45-degree field of view · retinal fundus photograph — 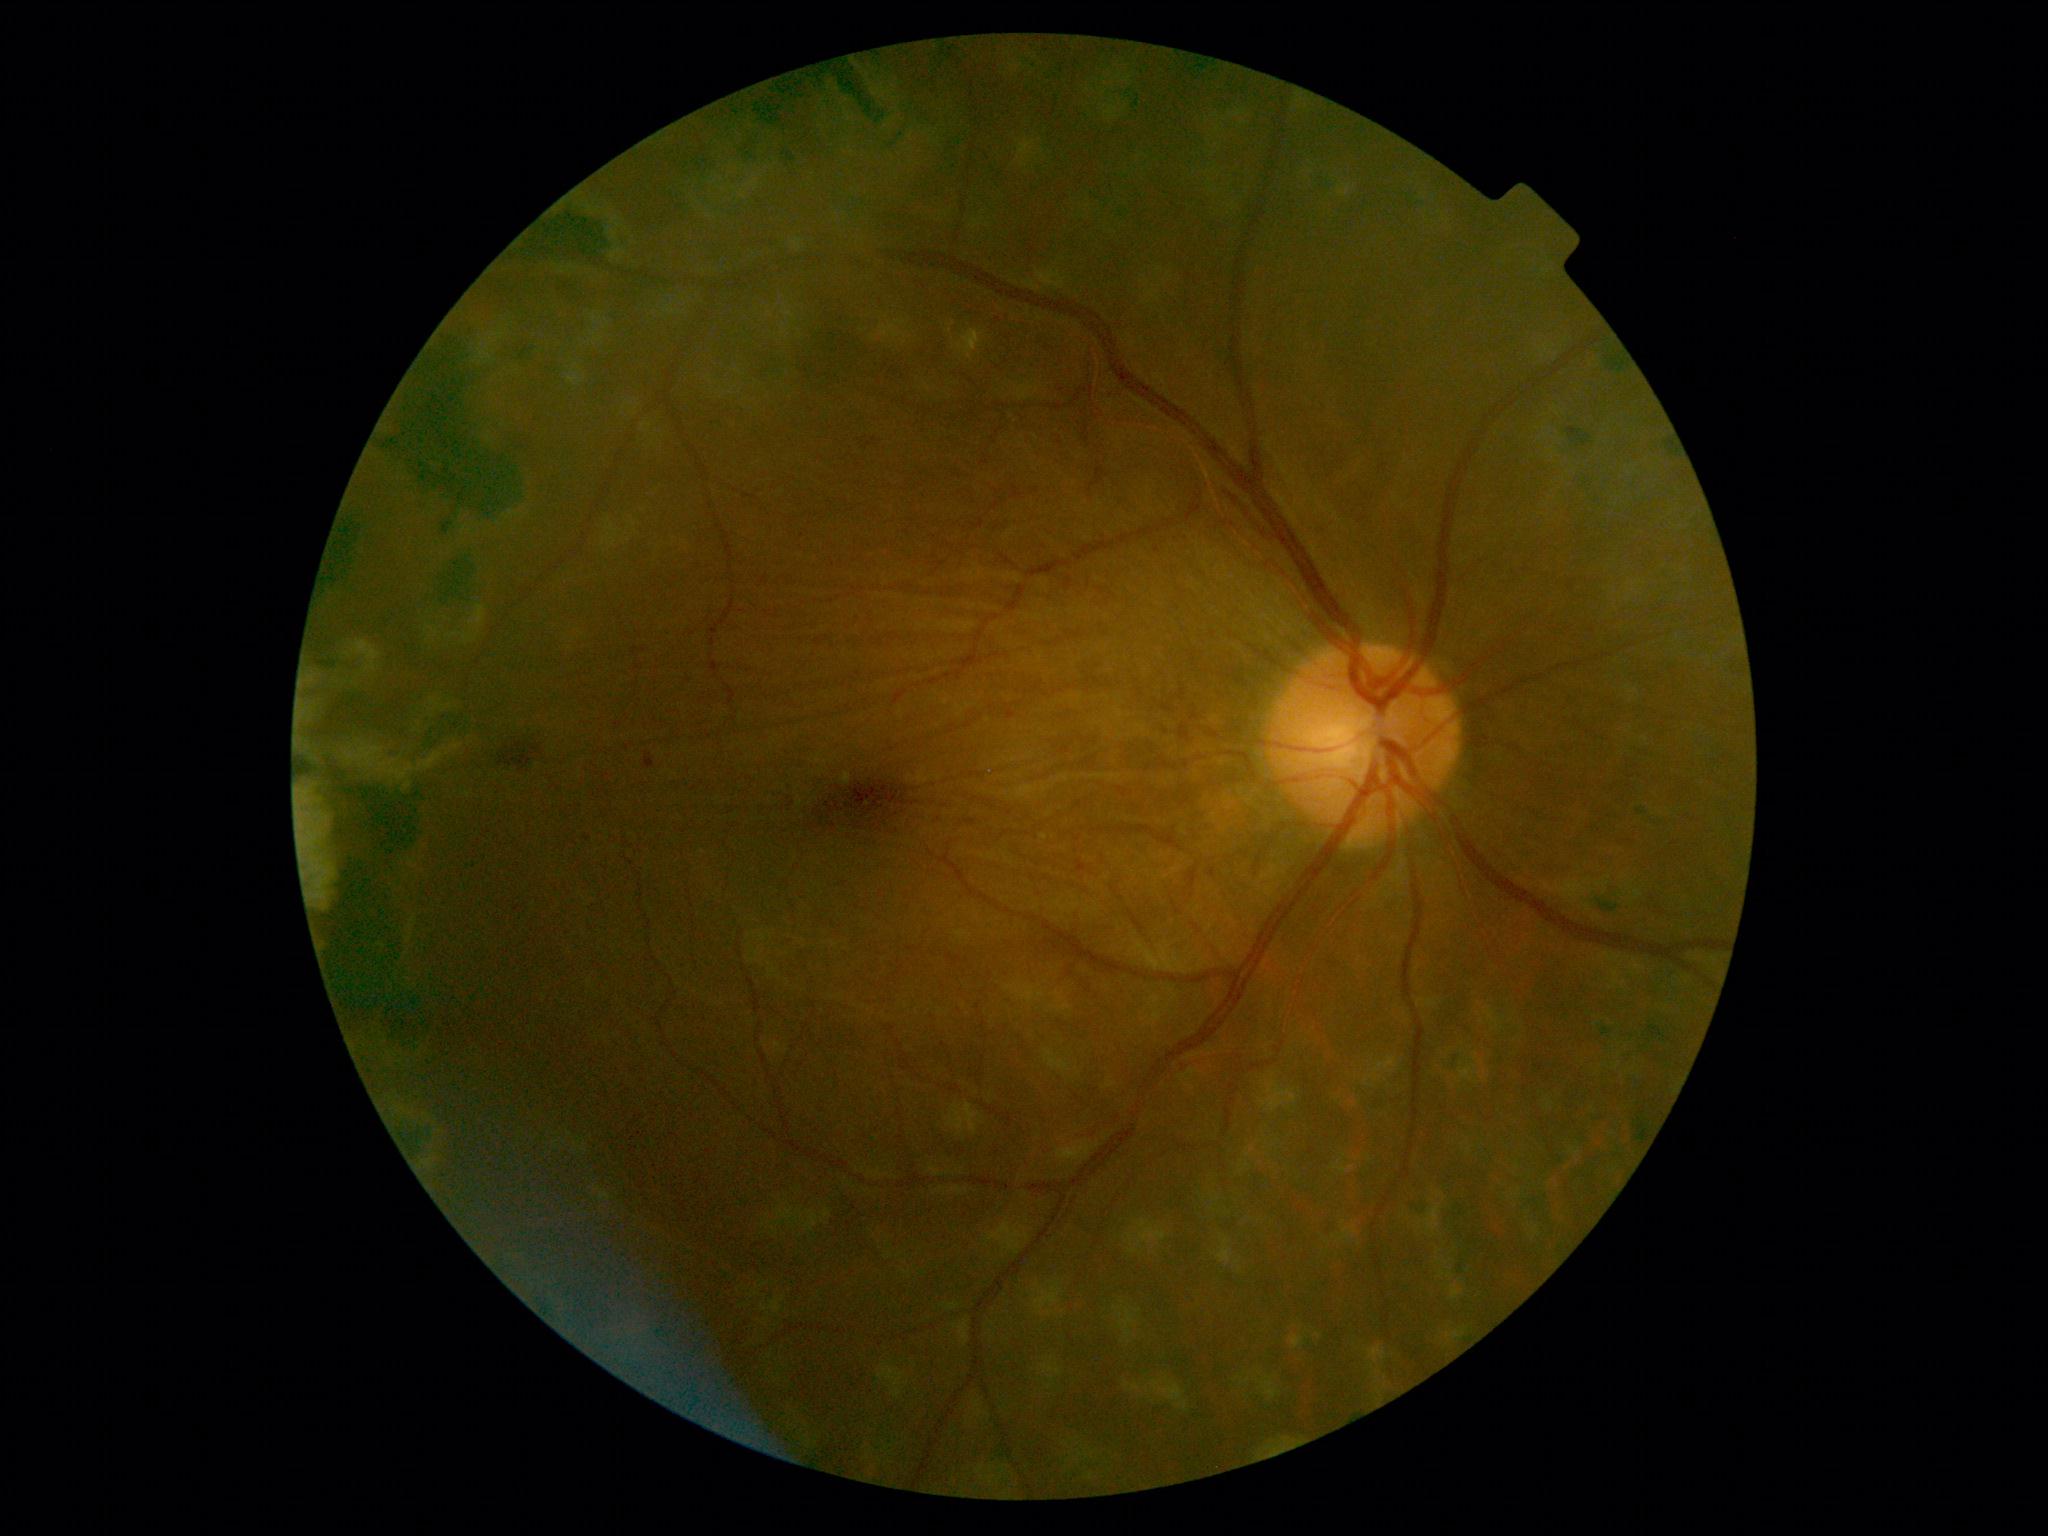
dr_grade: 2 — more than just microaneurysms but less than severe NPDR
dr_category: non-proliferative diabetic retinopathy